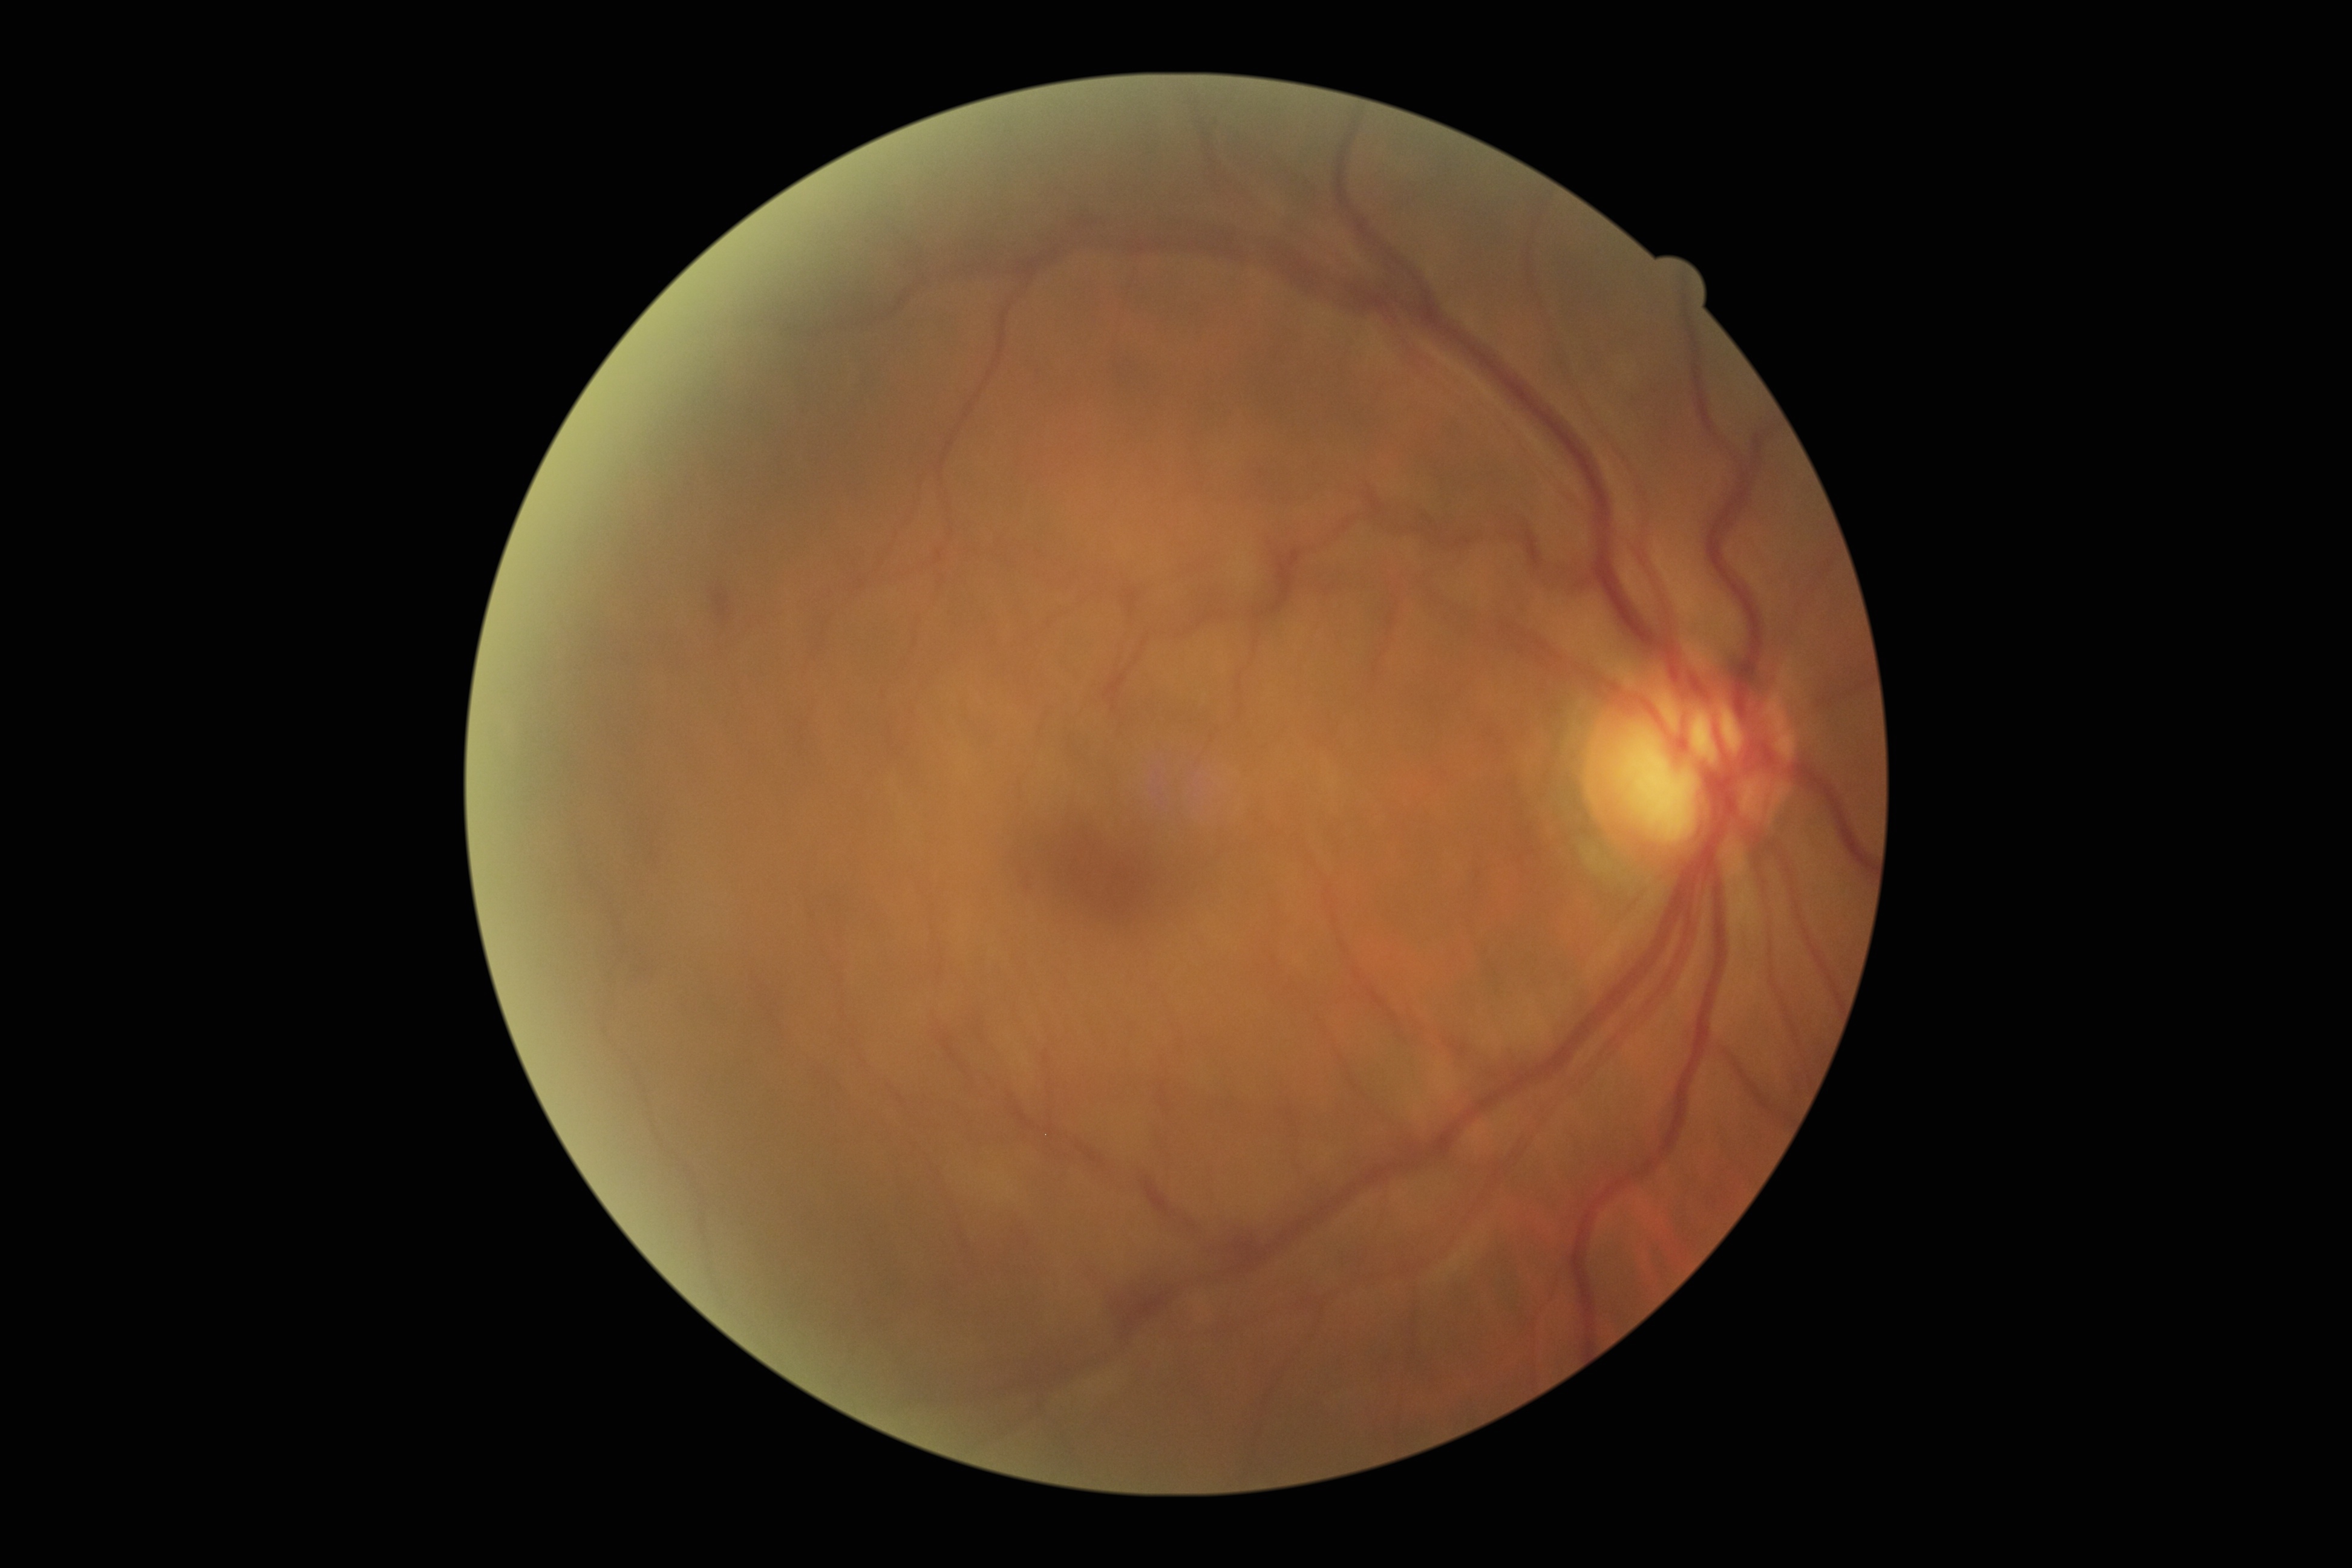

diabetic retinopathy@grade 2.